Image size 2352x1568; color fundus photograph — 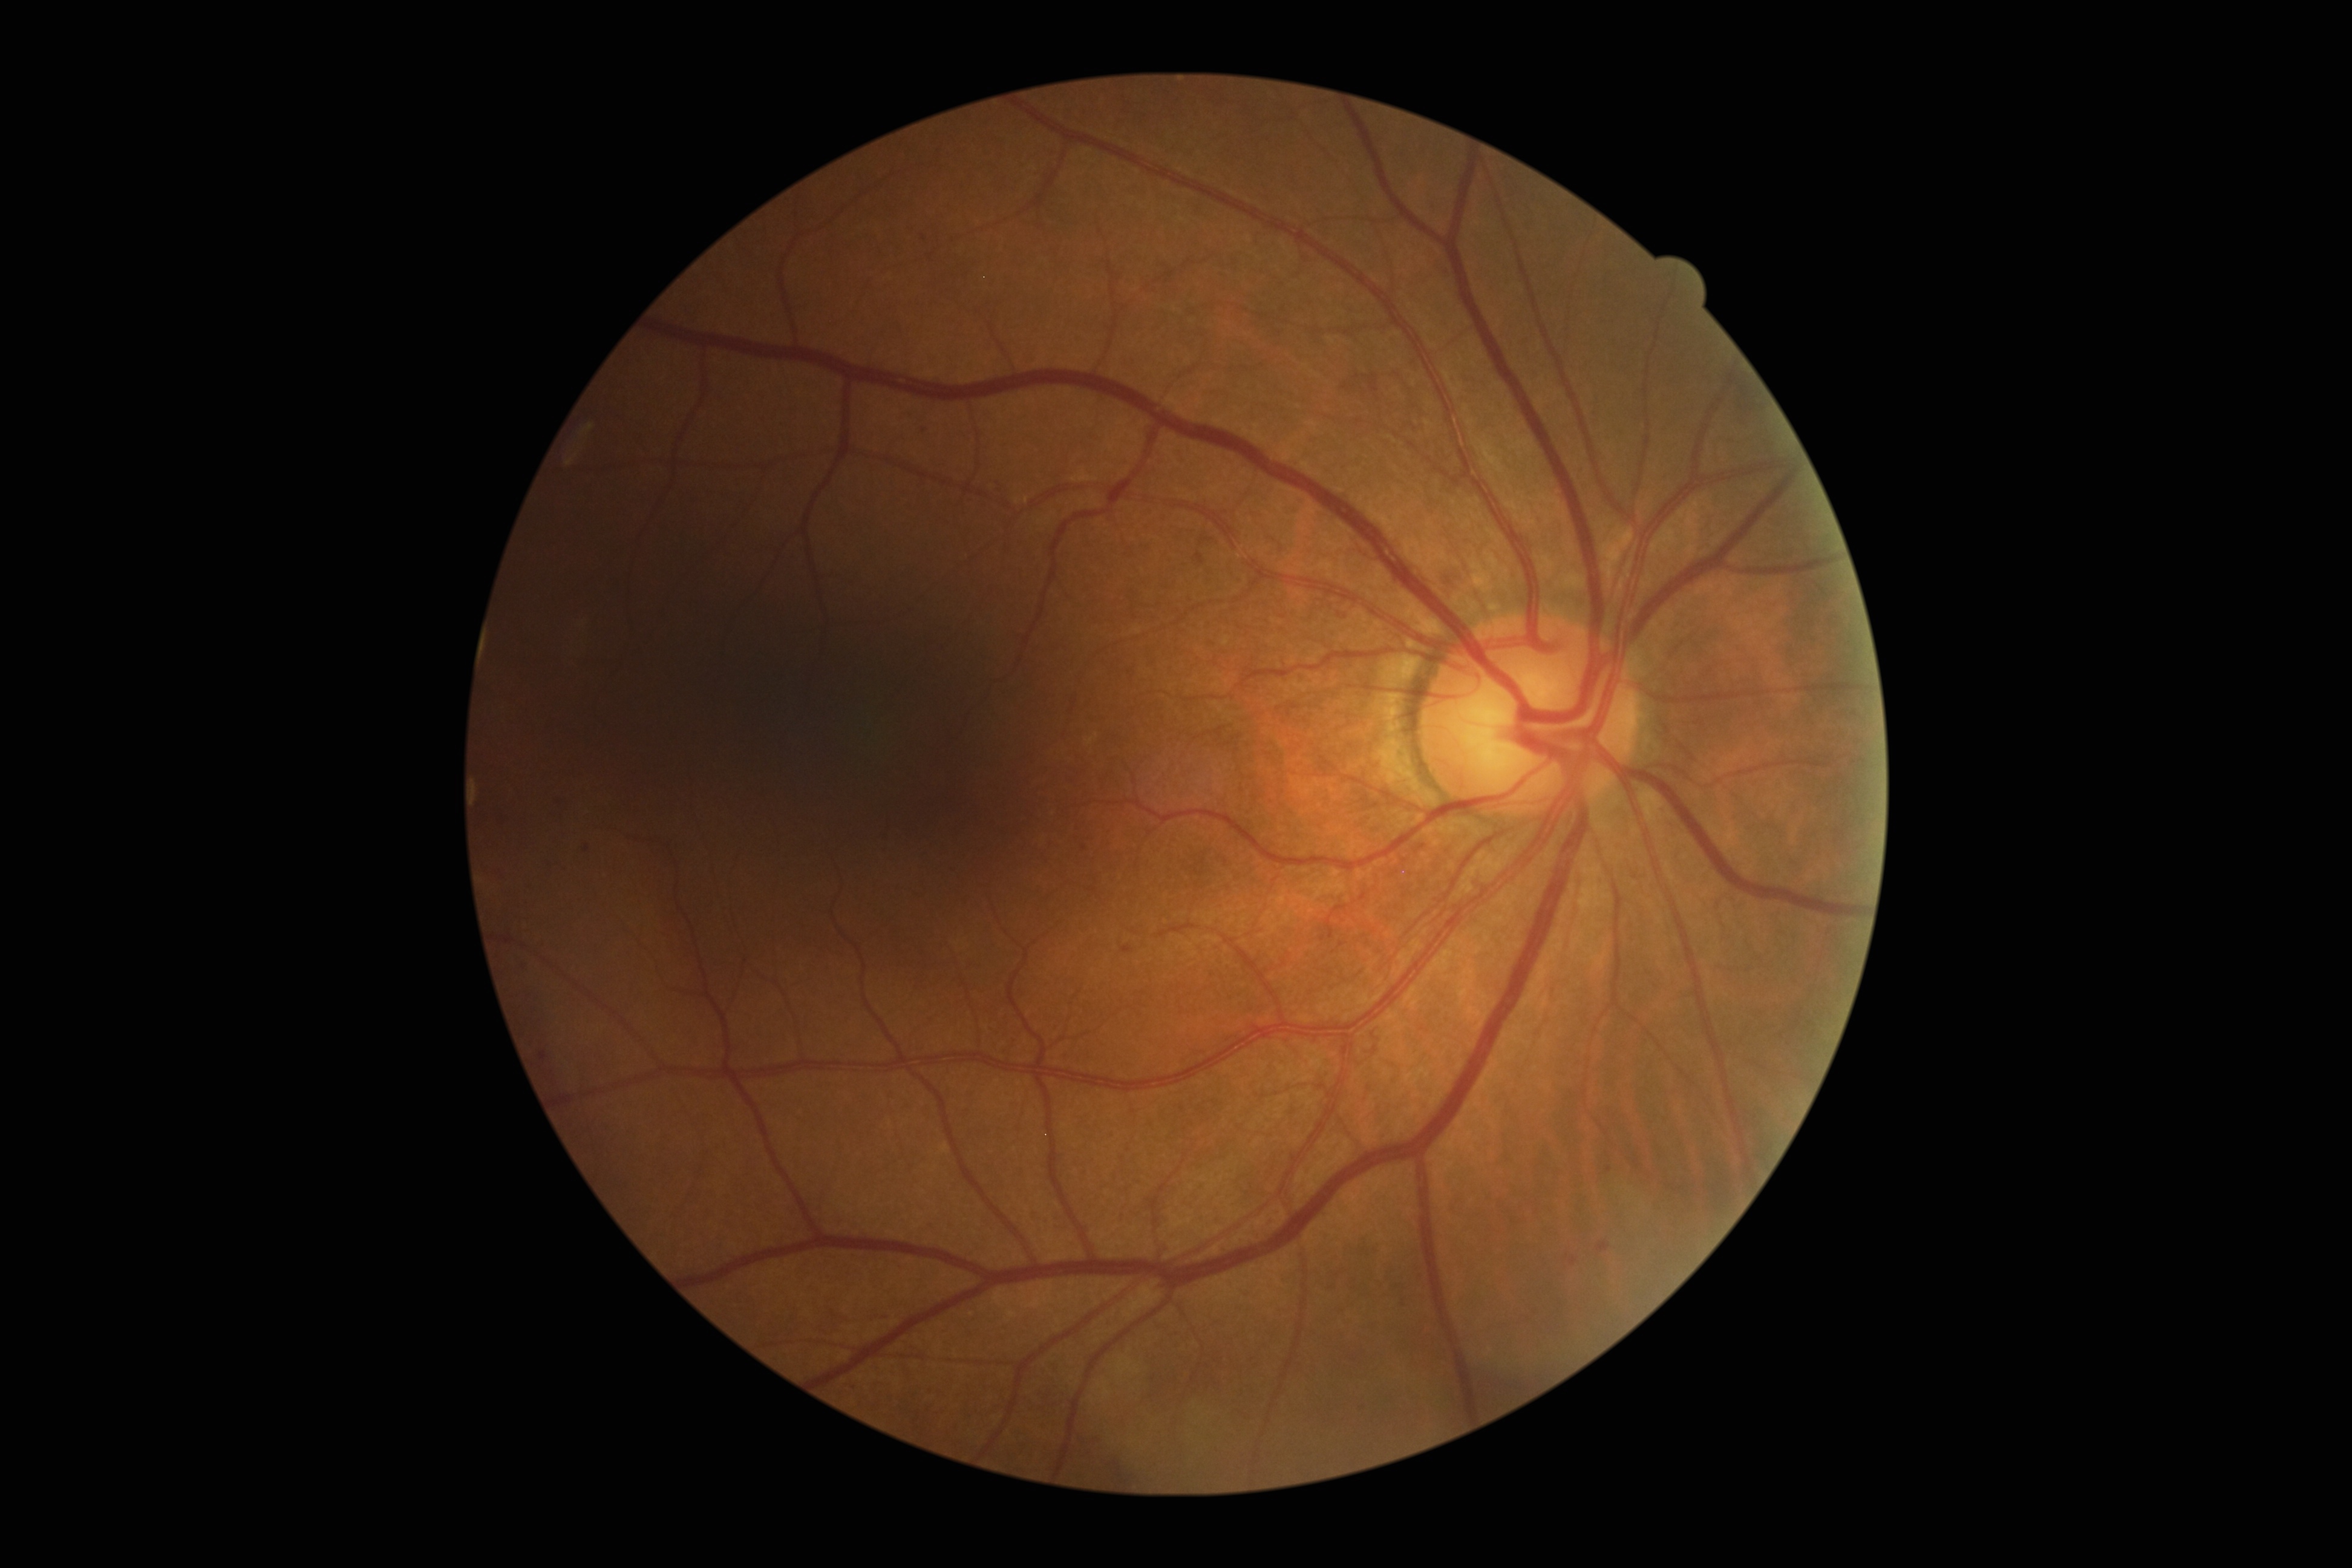
Retinopathy is grade 2 (moderate NPDR). Disease class: non-proliferative diabetic retinopathy.